Portable fundus camera image. 60° FOV:
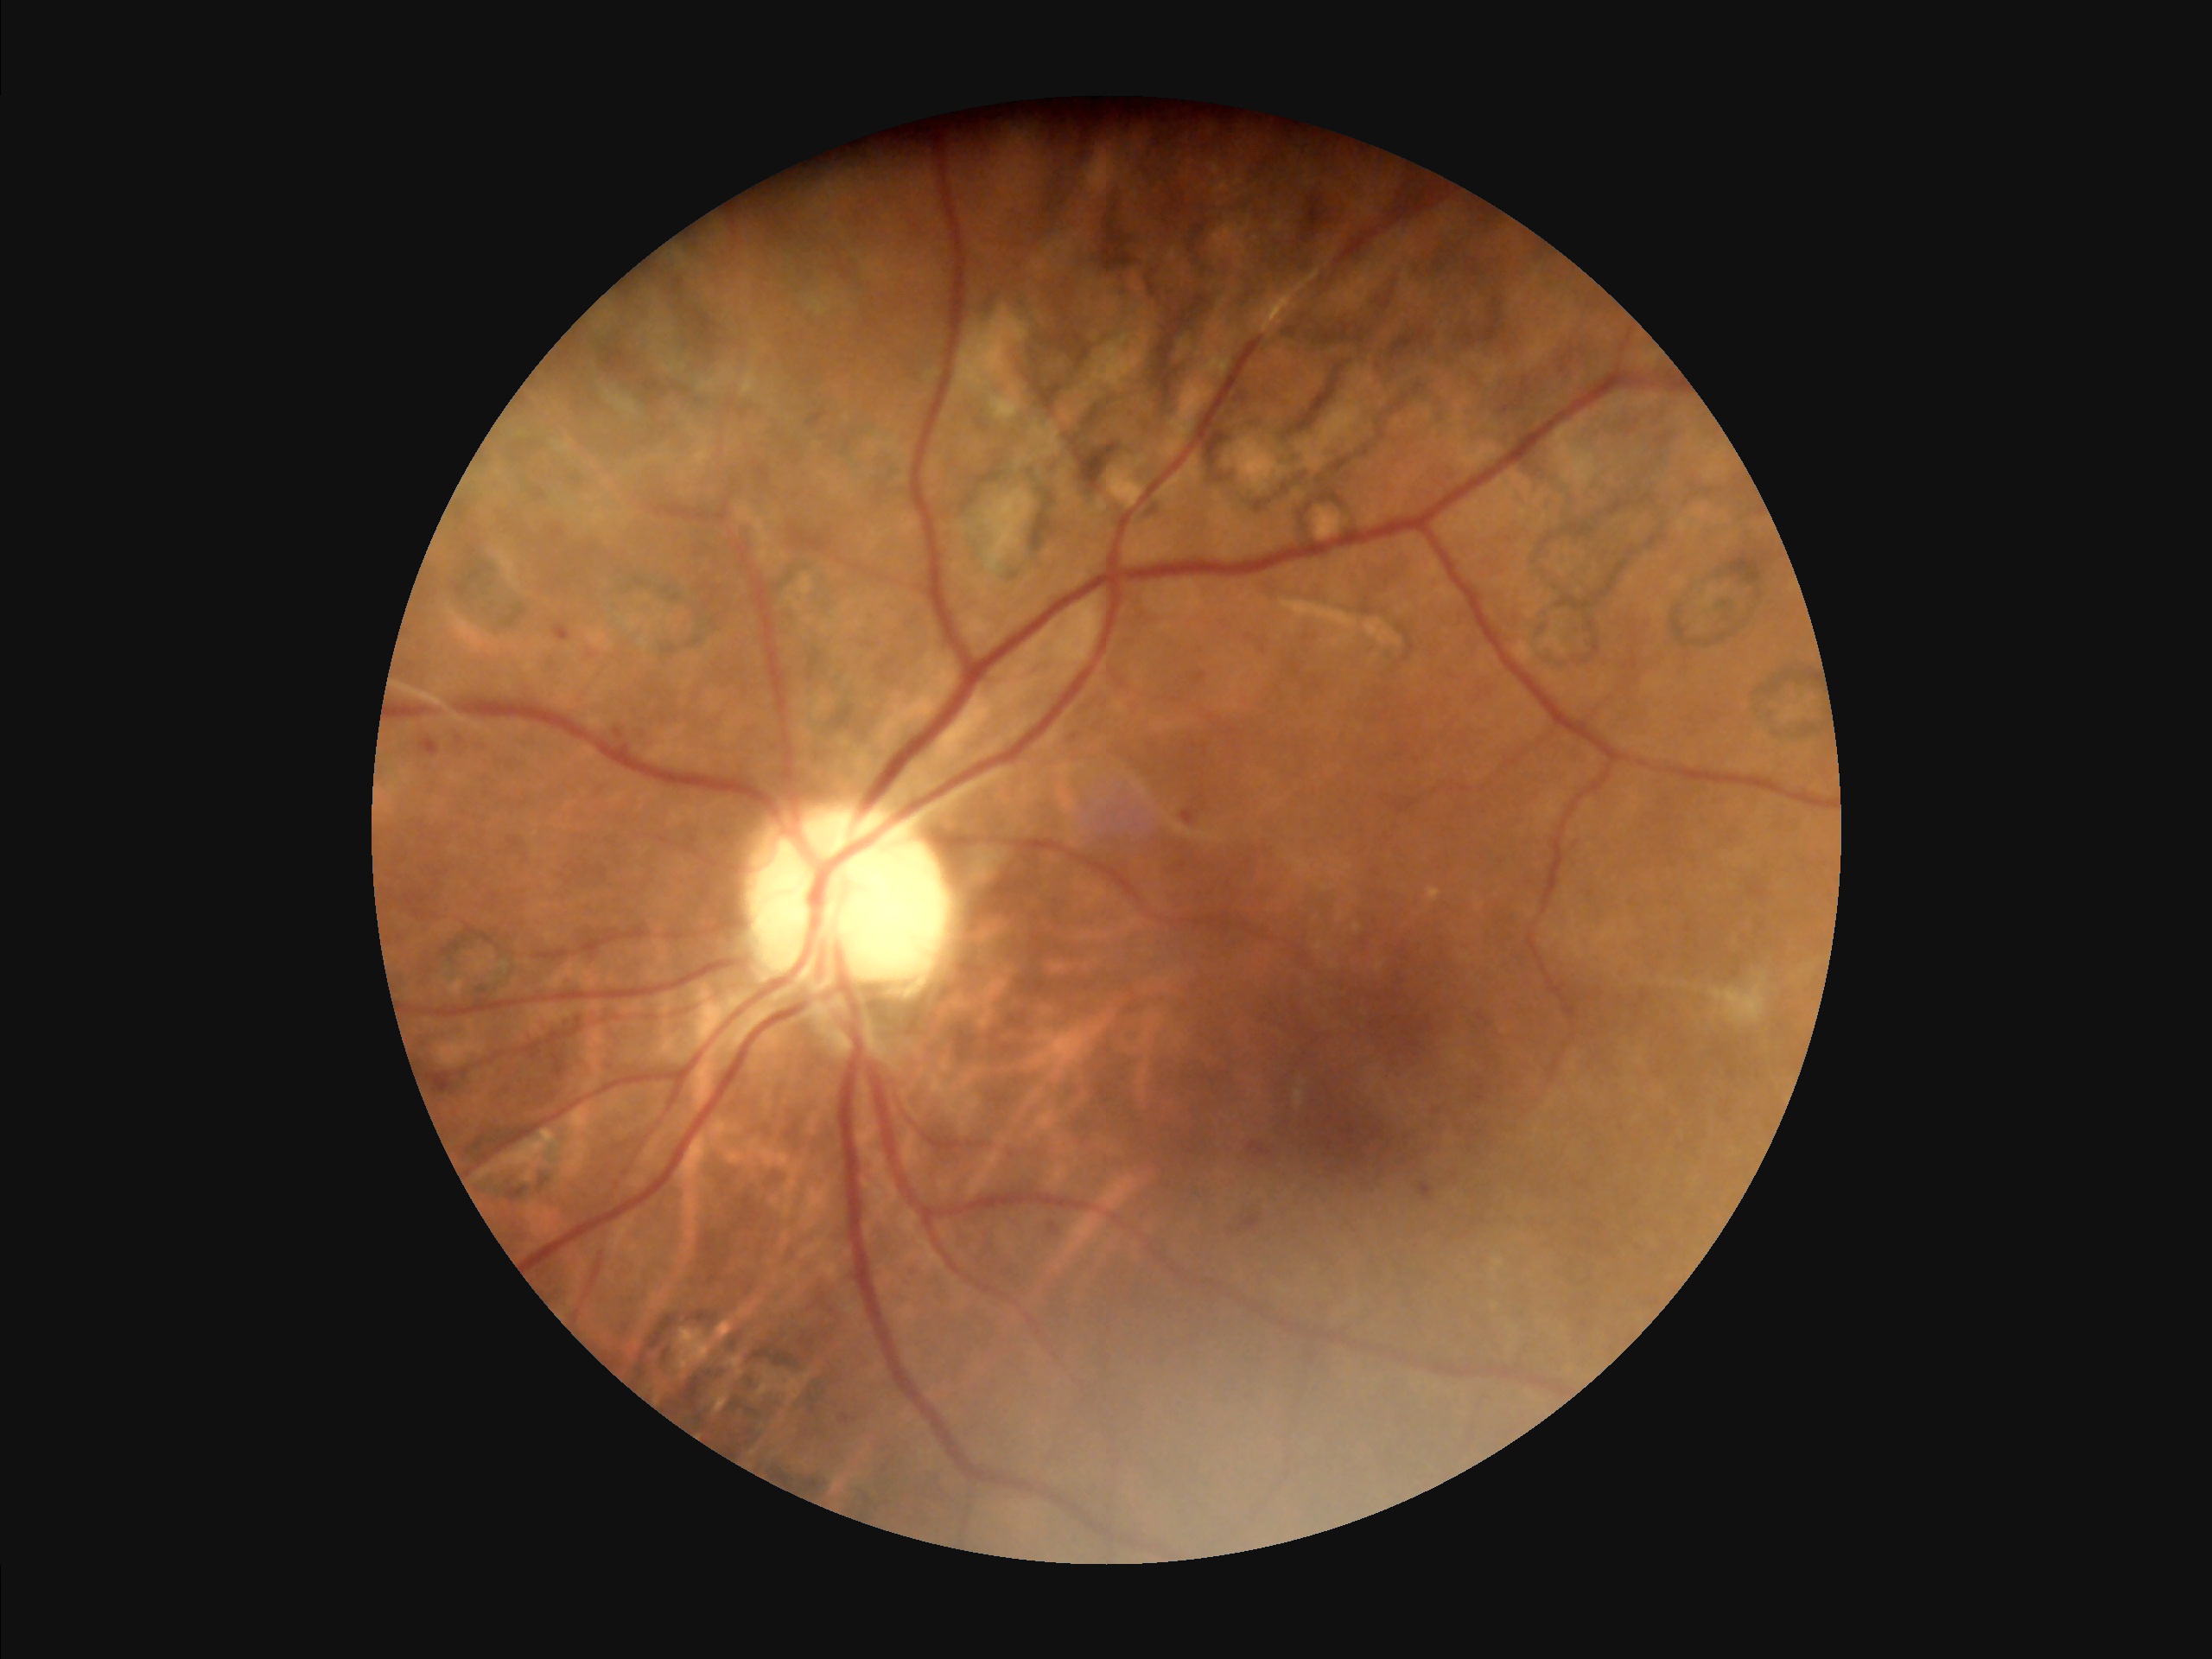 Quality grading:
- overall: satisfactory
- contrast: satisfactory
- illumination/color: good
- sharpness: good